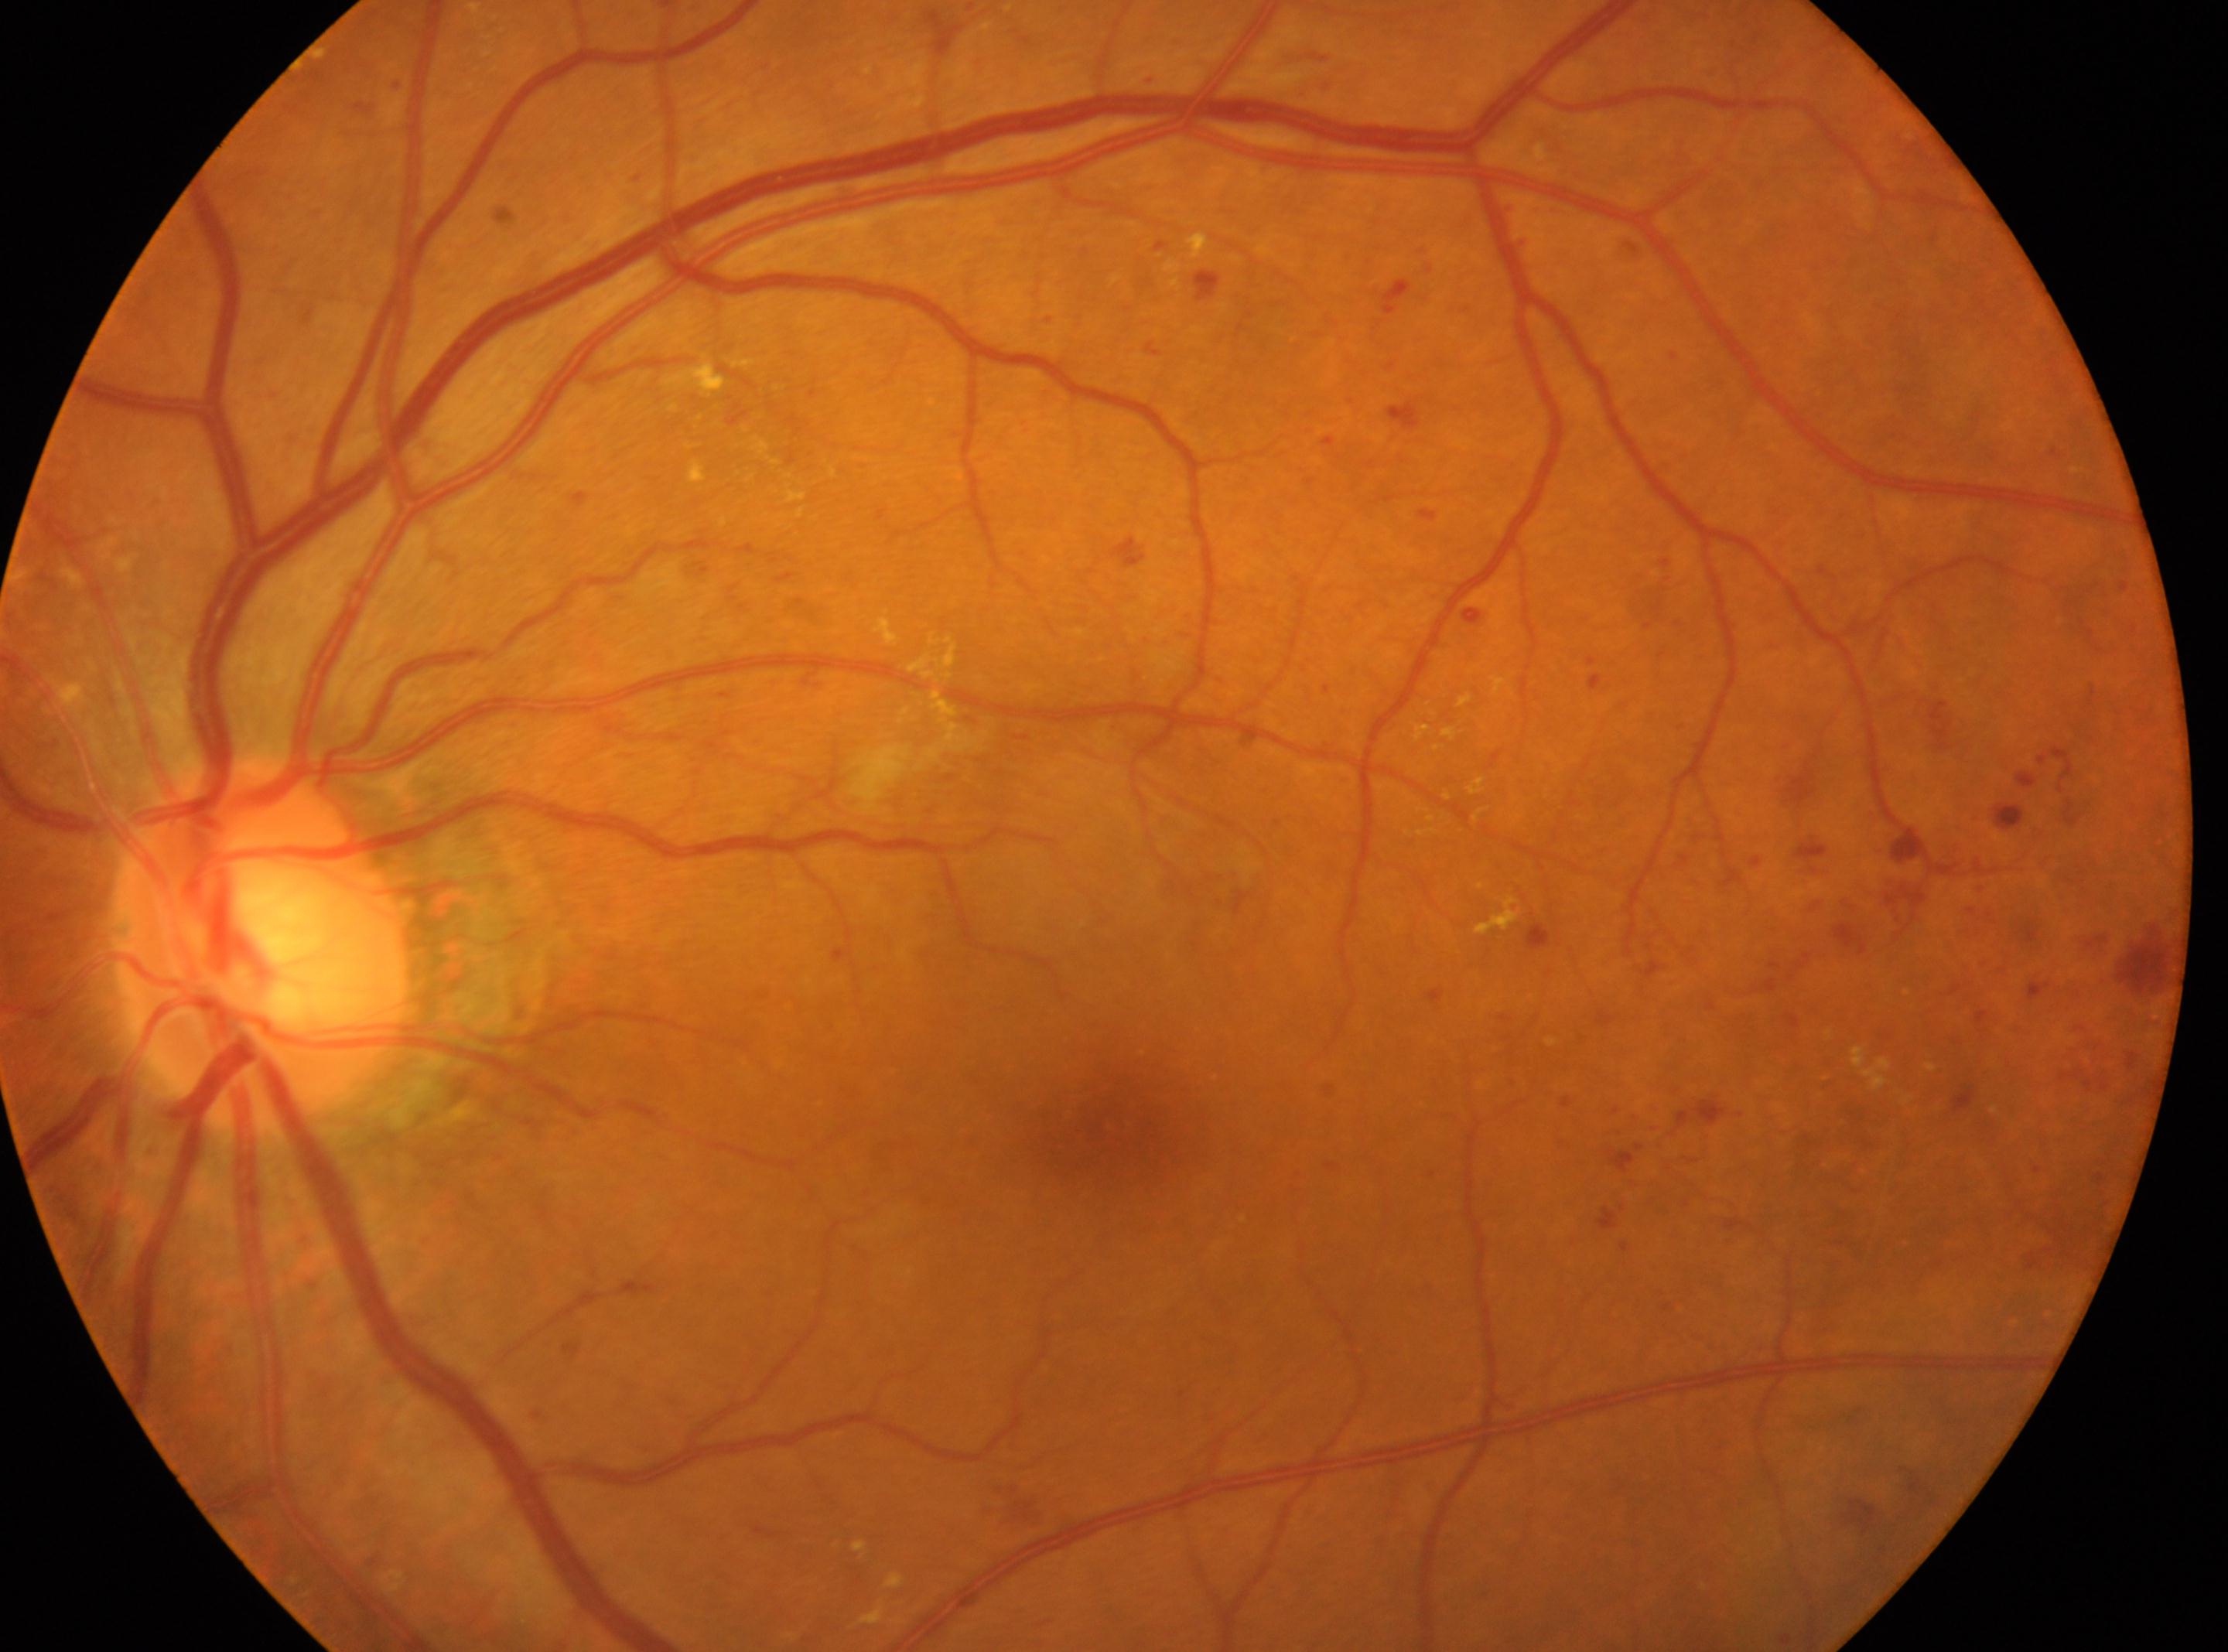
left | the fovea: (x: 1112, y: 1138) | retinopathy: 2/4 | optic disc center: (x: 261, y: 944).